848 x 848 pixels · nonmydriatic fundus photograph · color fundus image — 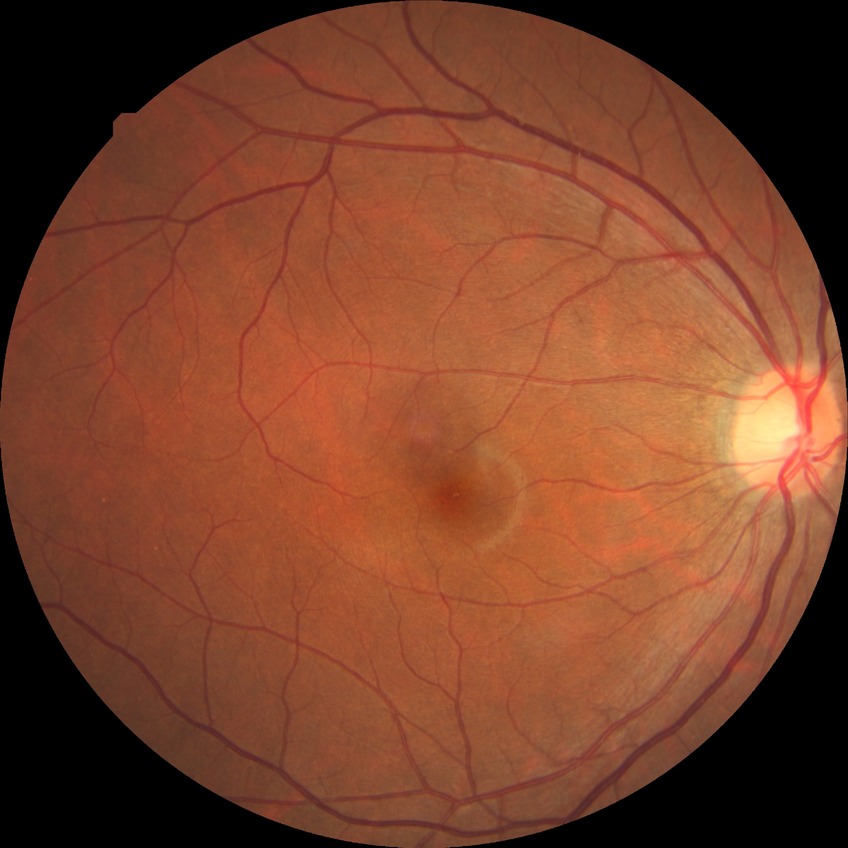

Diabetic retinopathy (DR) is no diabetic retinopathy (NDR).